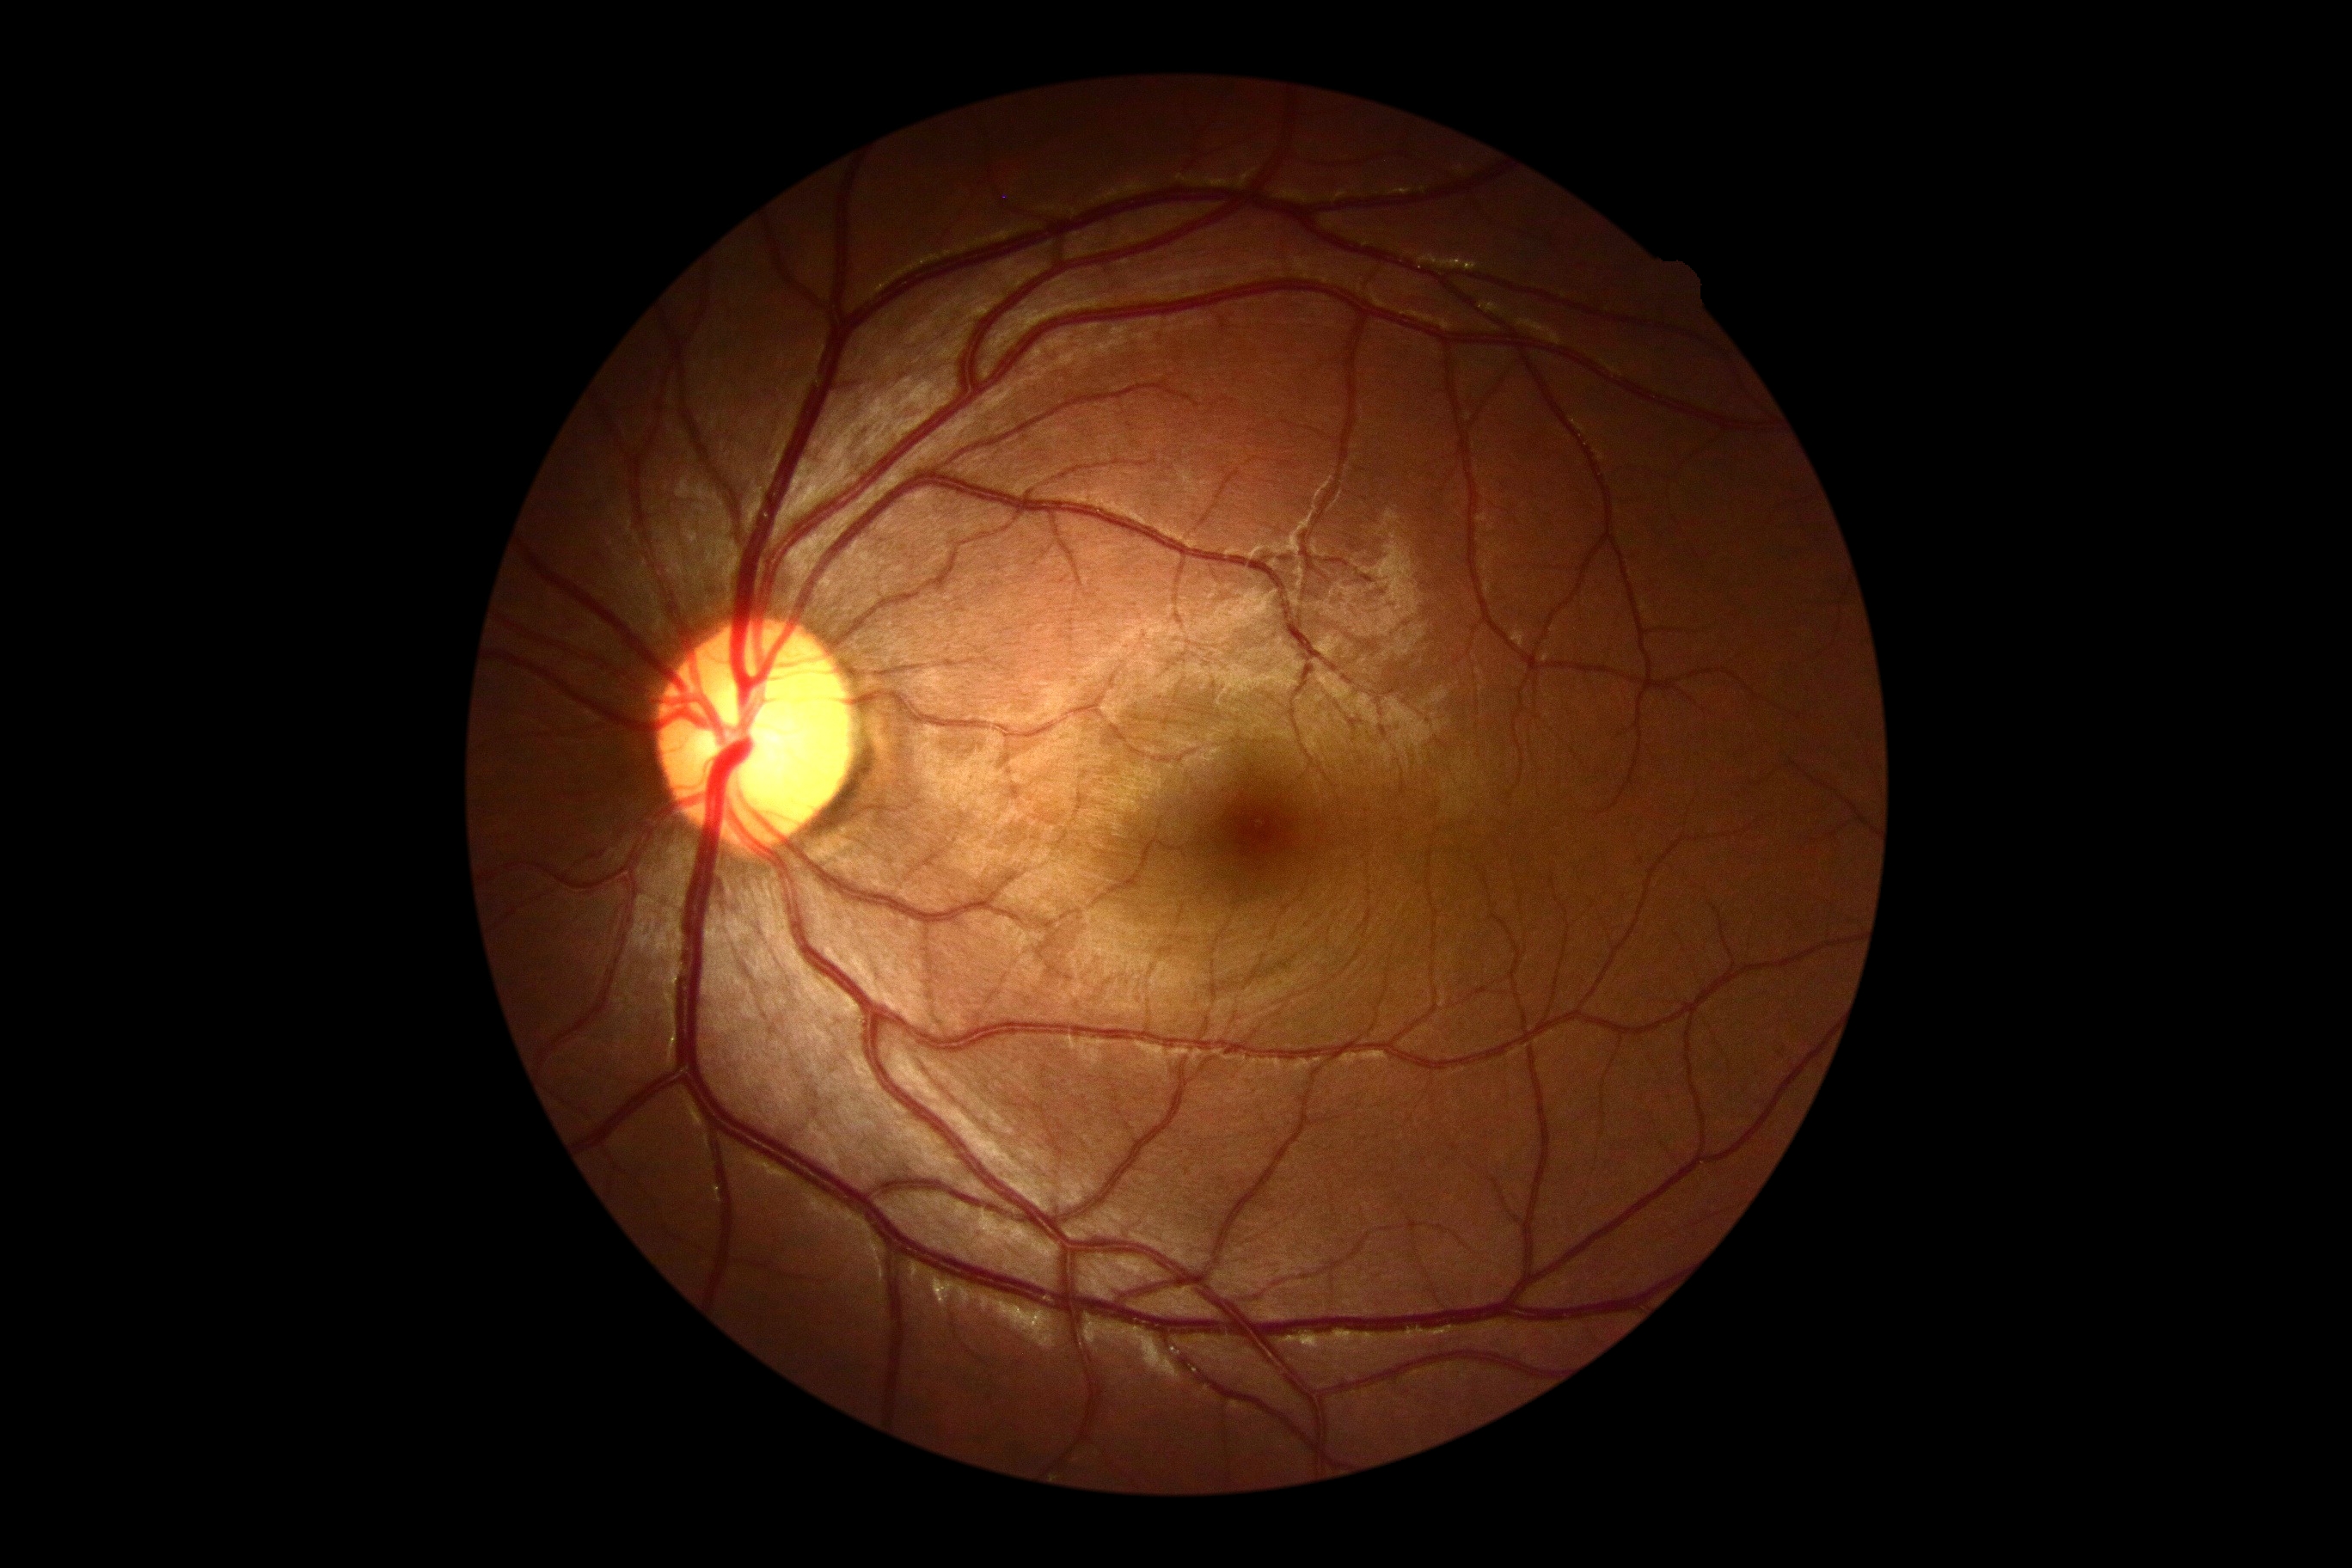

dr_grade: grade 0 (no apparent retinopathy)